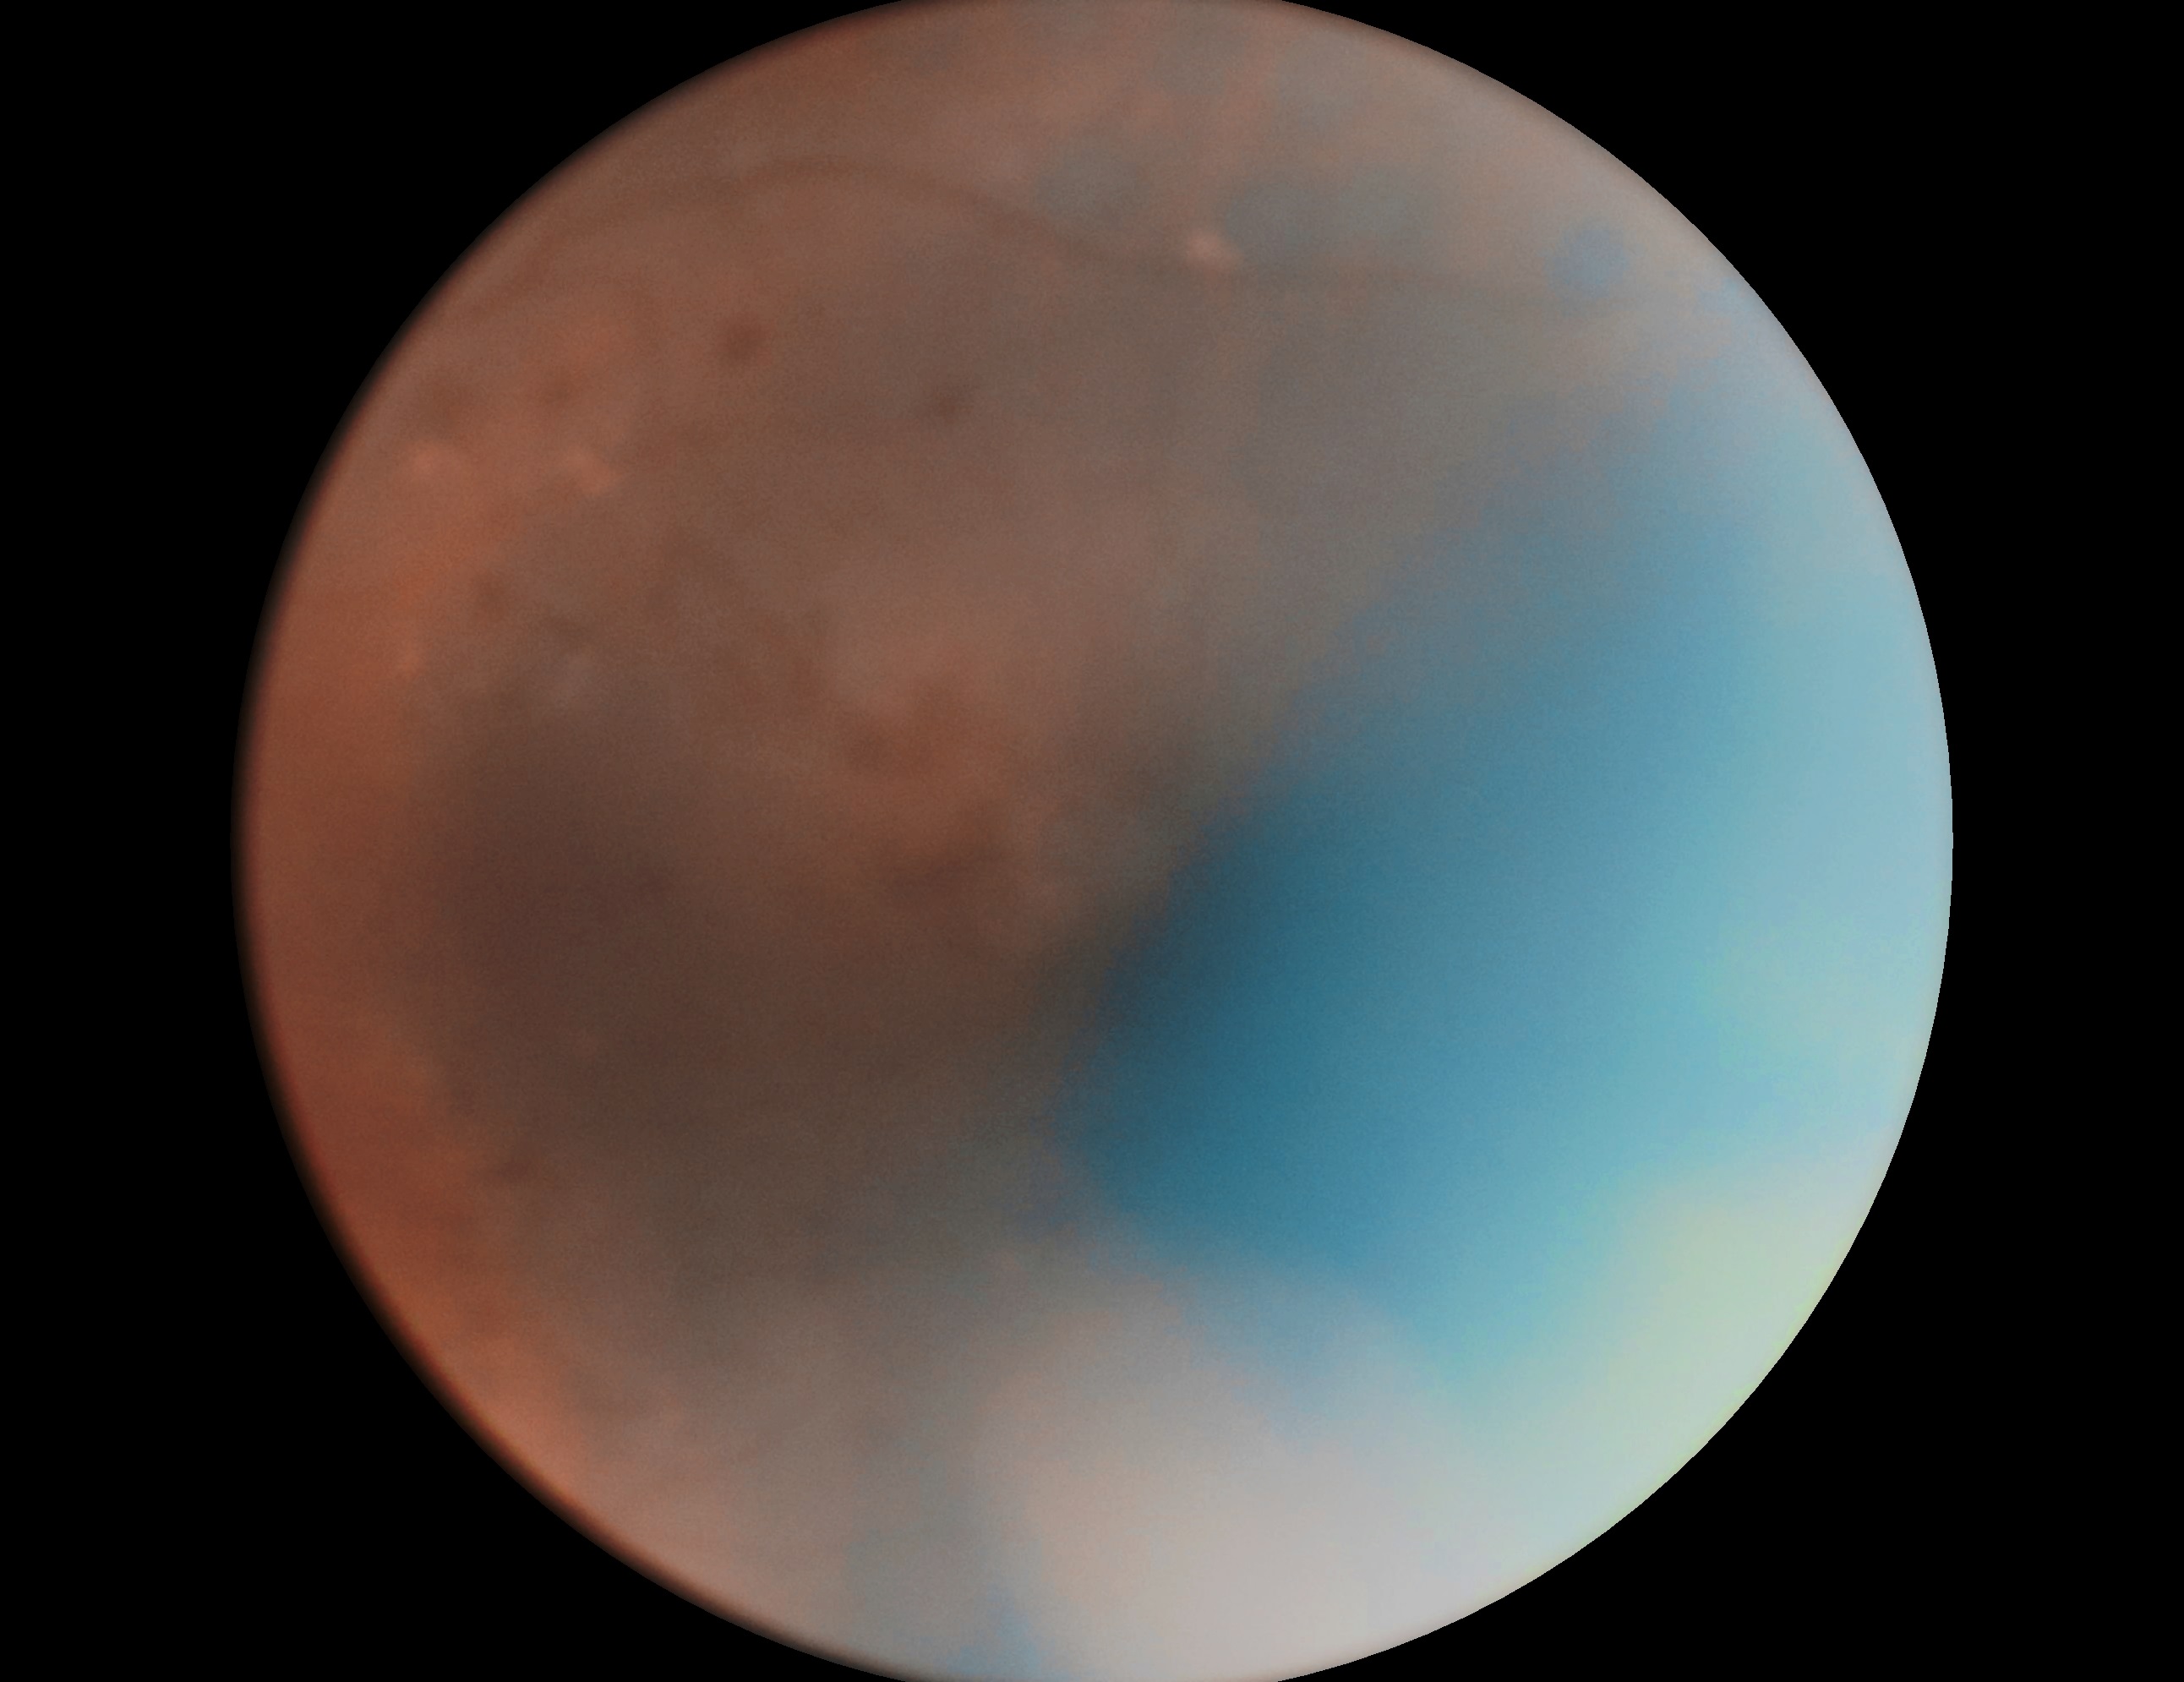 DR stage=moderate non-proliferative diabetic retinopathy (grade 2).